Infant wide-field fundus photograph: 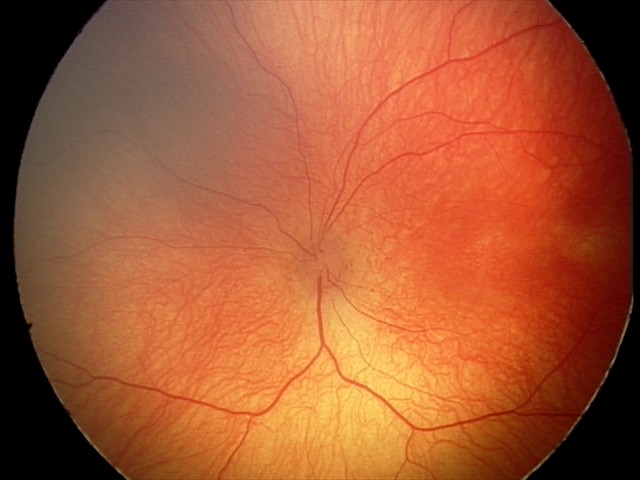
Plus disease absent.
From an examination with diagnosis of retinopathy of prematurity stage 2 — ridge with height and width at the demarcation line.